Non-mydriatic acquisition
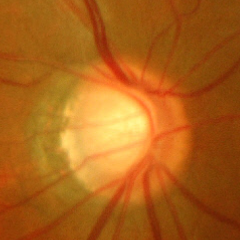 This fundus photograph shows advanced glaucoma.